45° field of view: 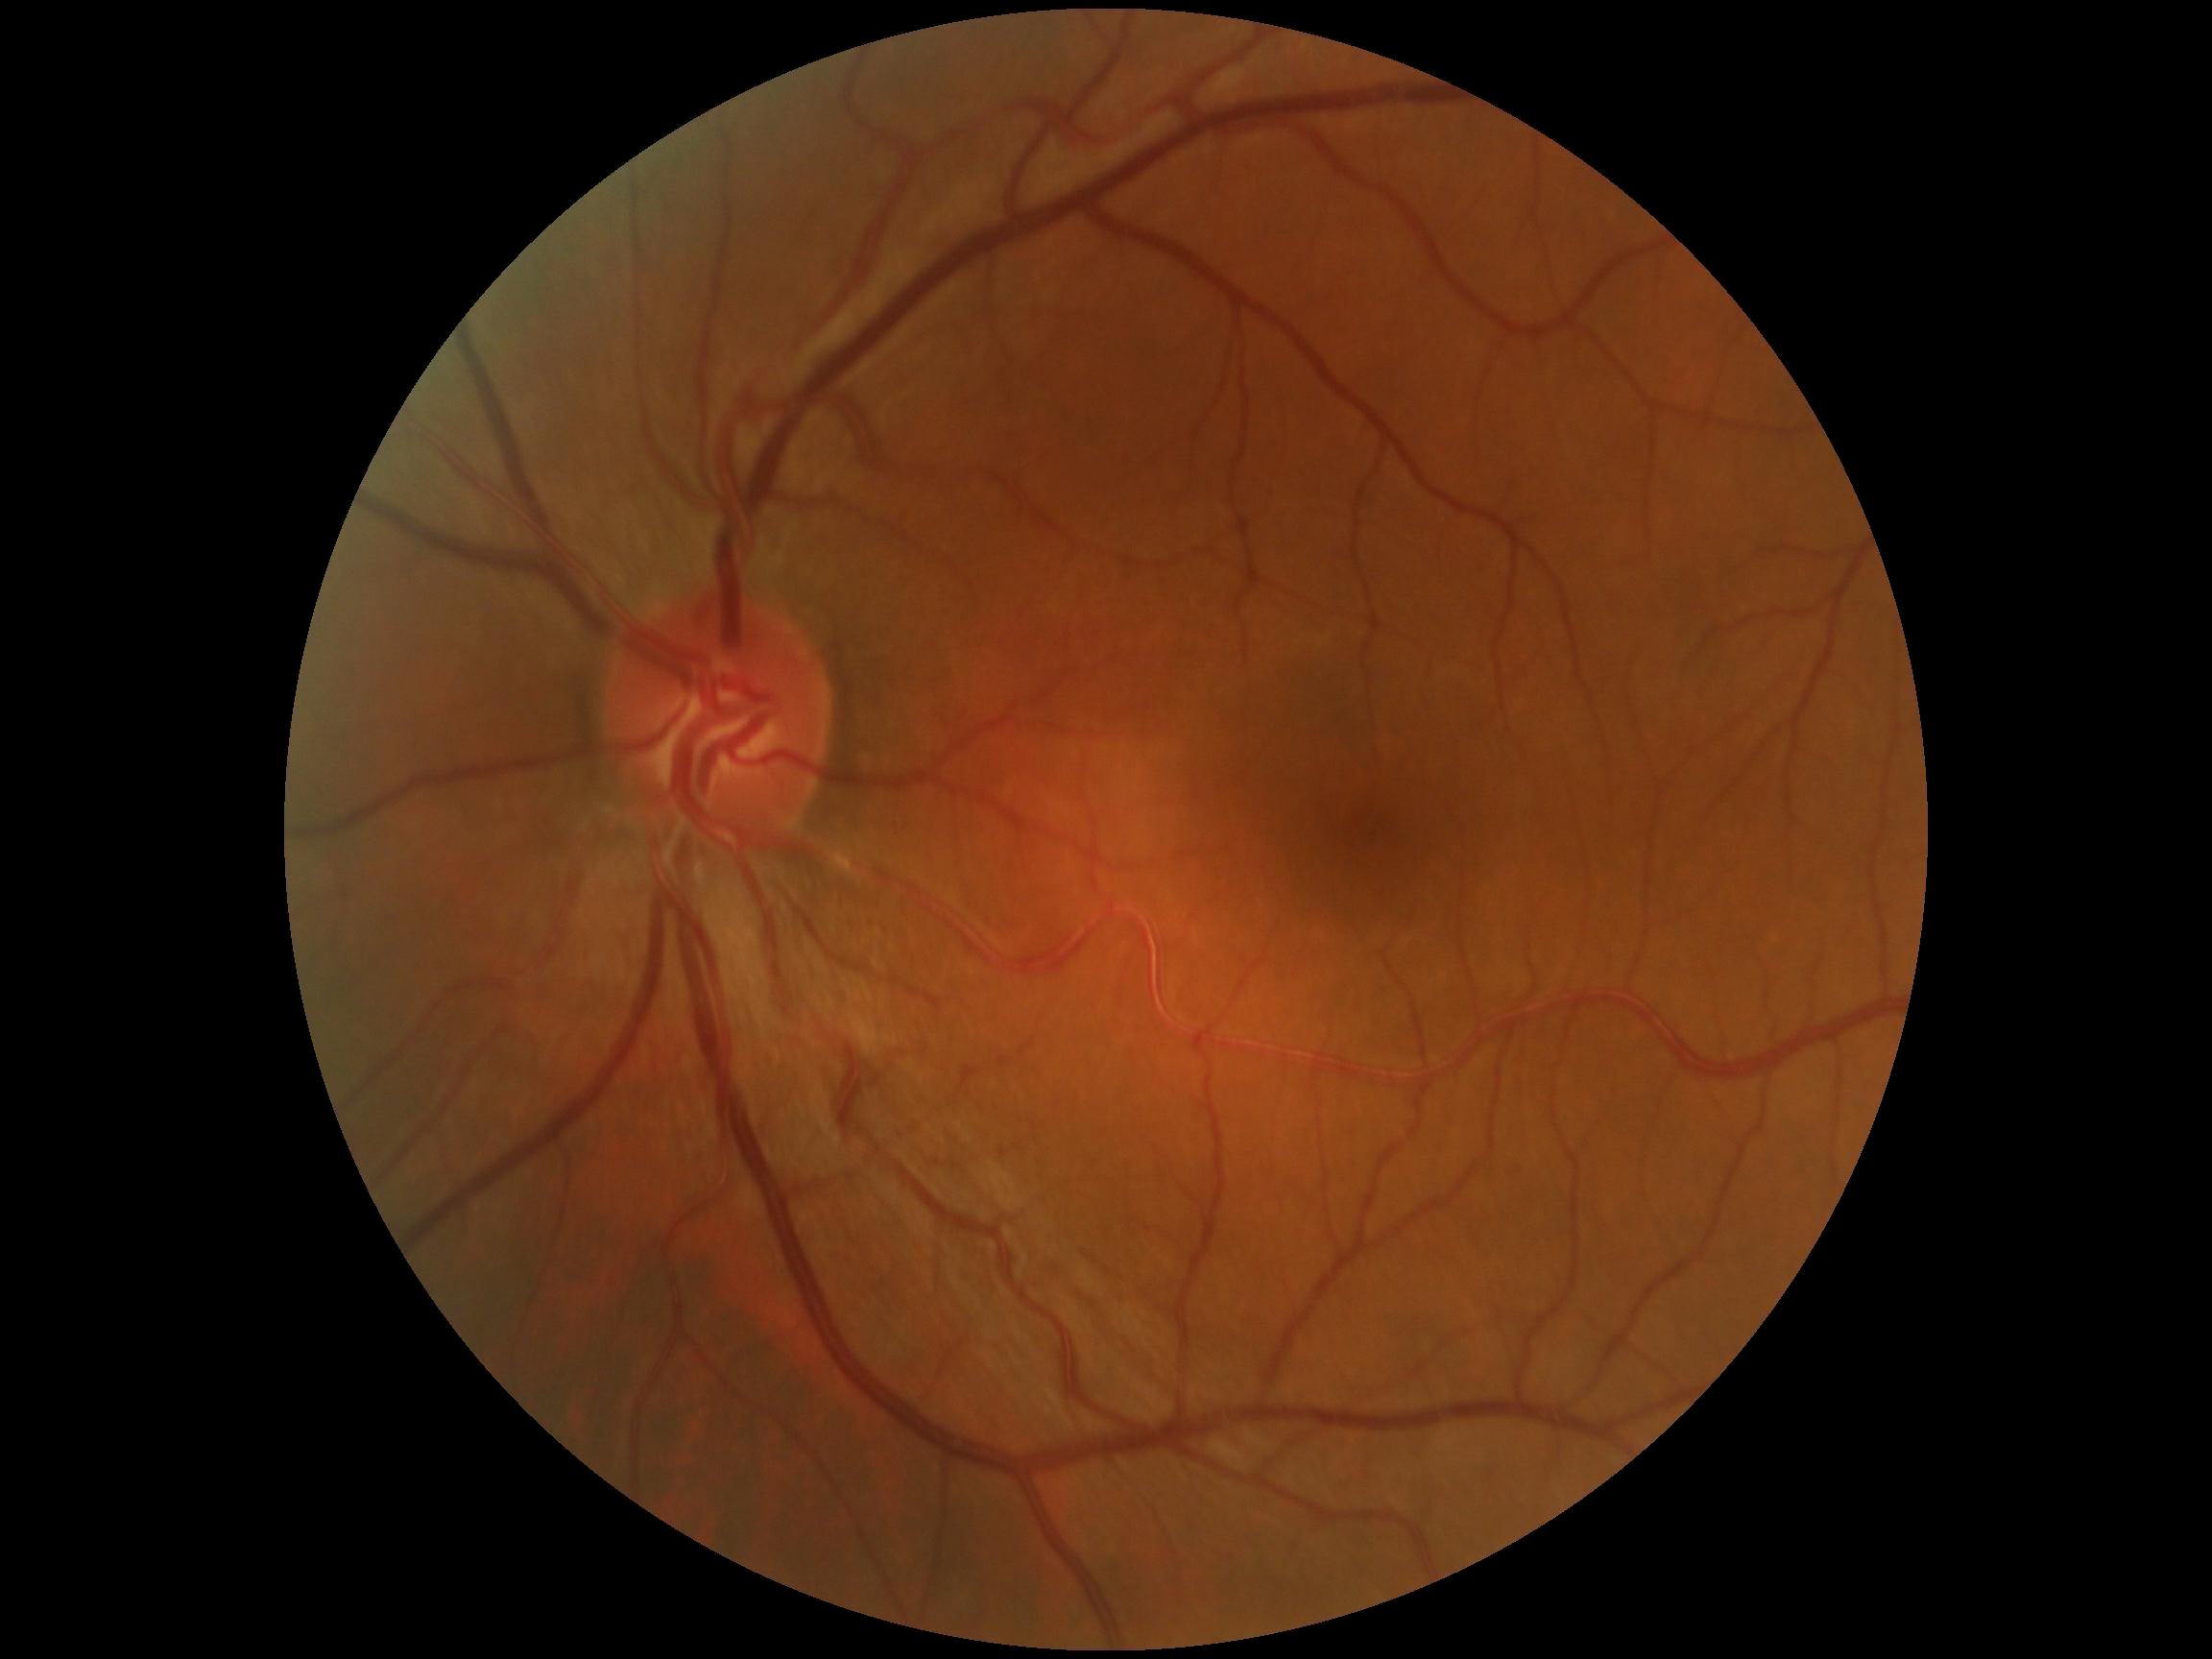 DR: grade 0 (no apparent retinopathy).